DR severity per modified Davis staging. 848 x 848 pixels. 45 degree fundus photograph. Acquired with a NIDEK AFC-230. Retinal fundus photograph: 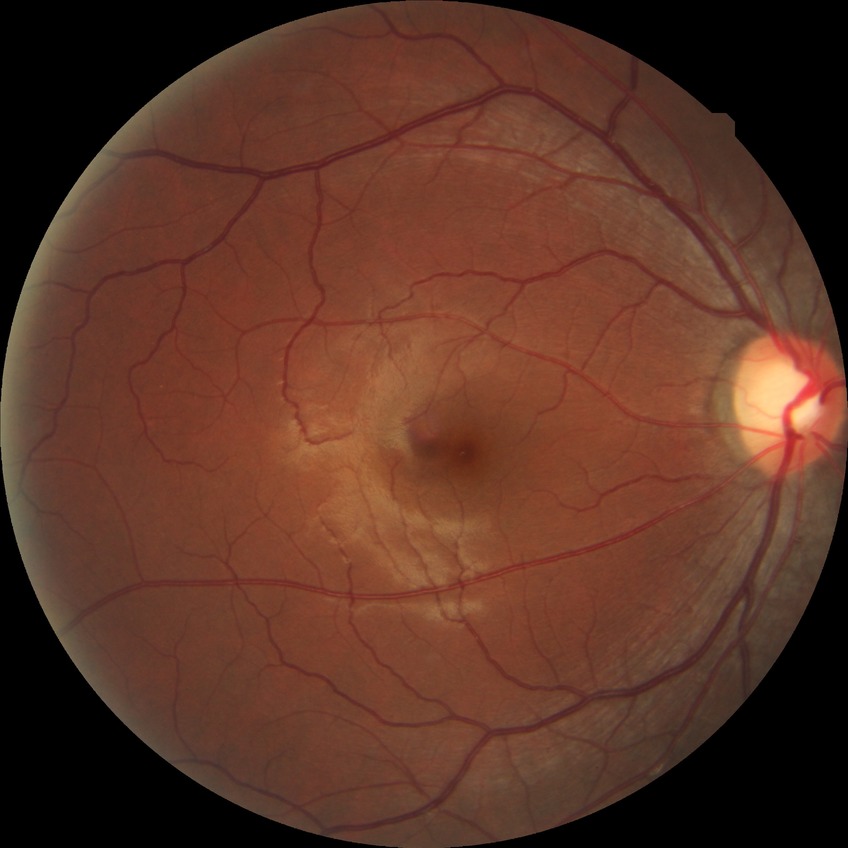

Retinopathy stage: no diabetic retinopathy.